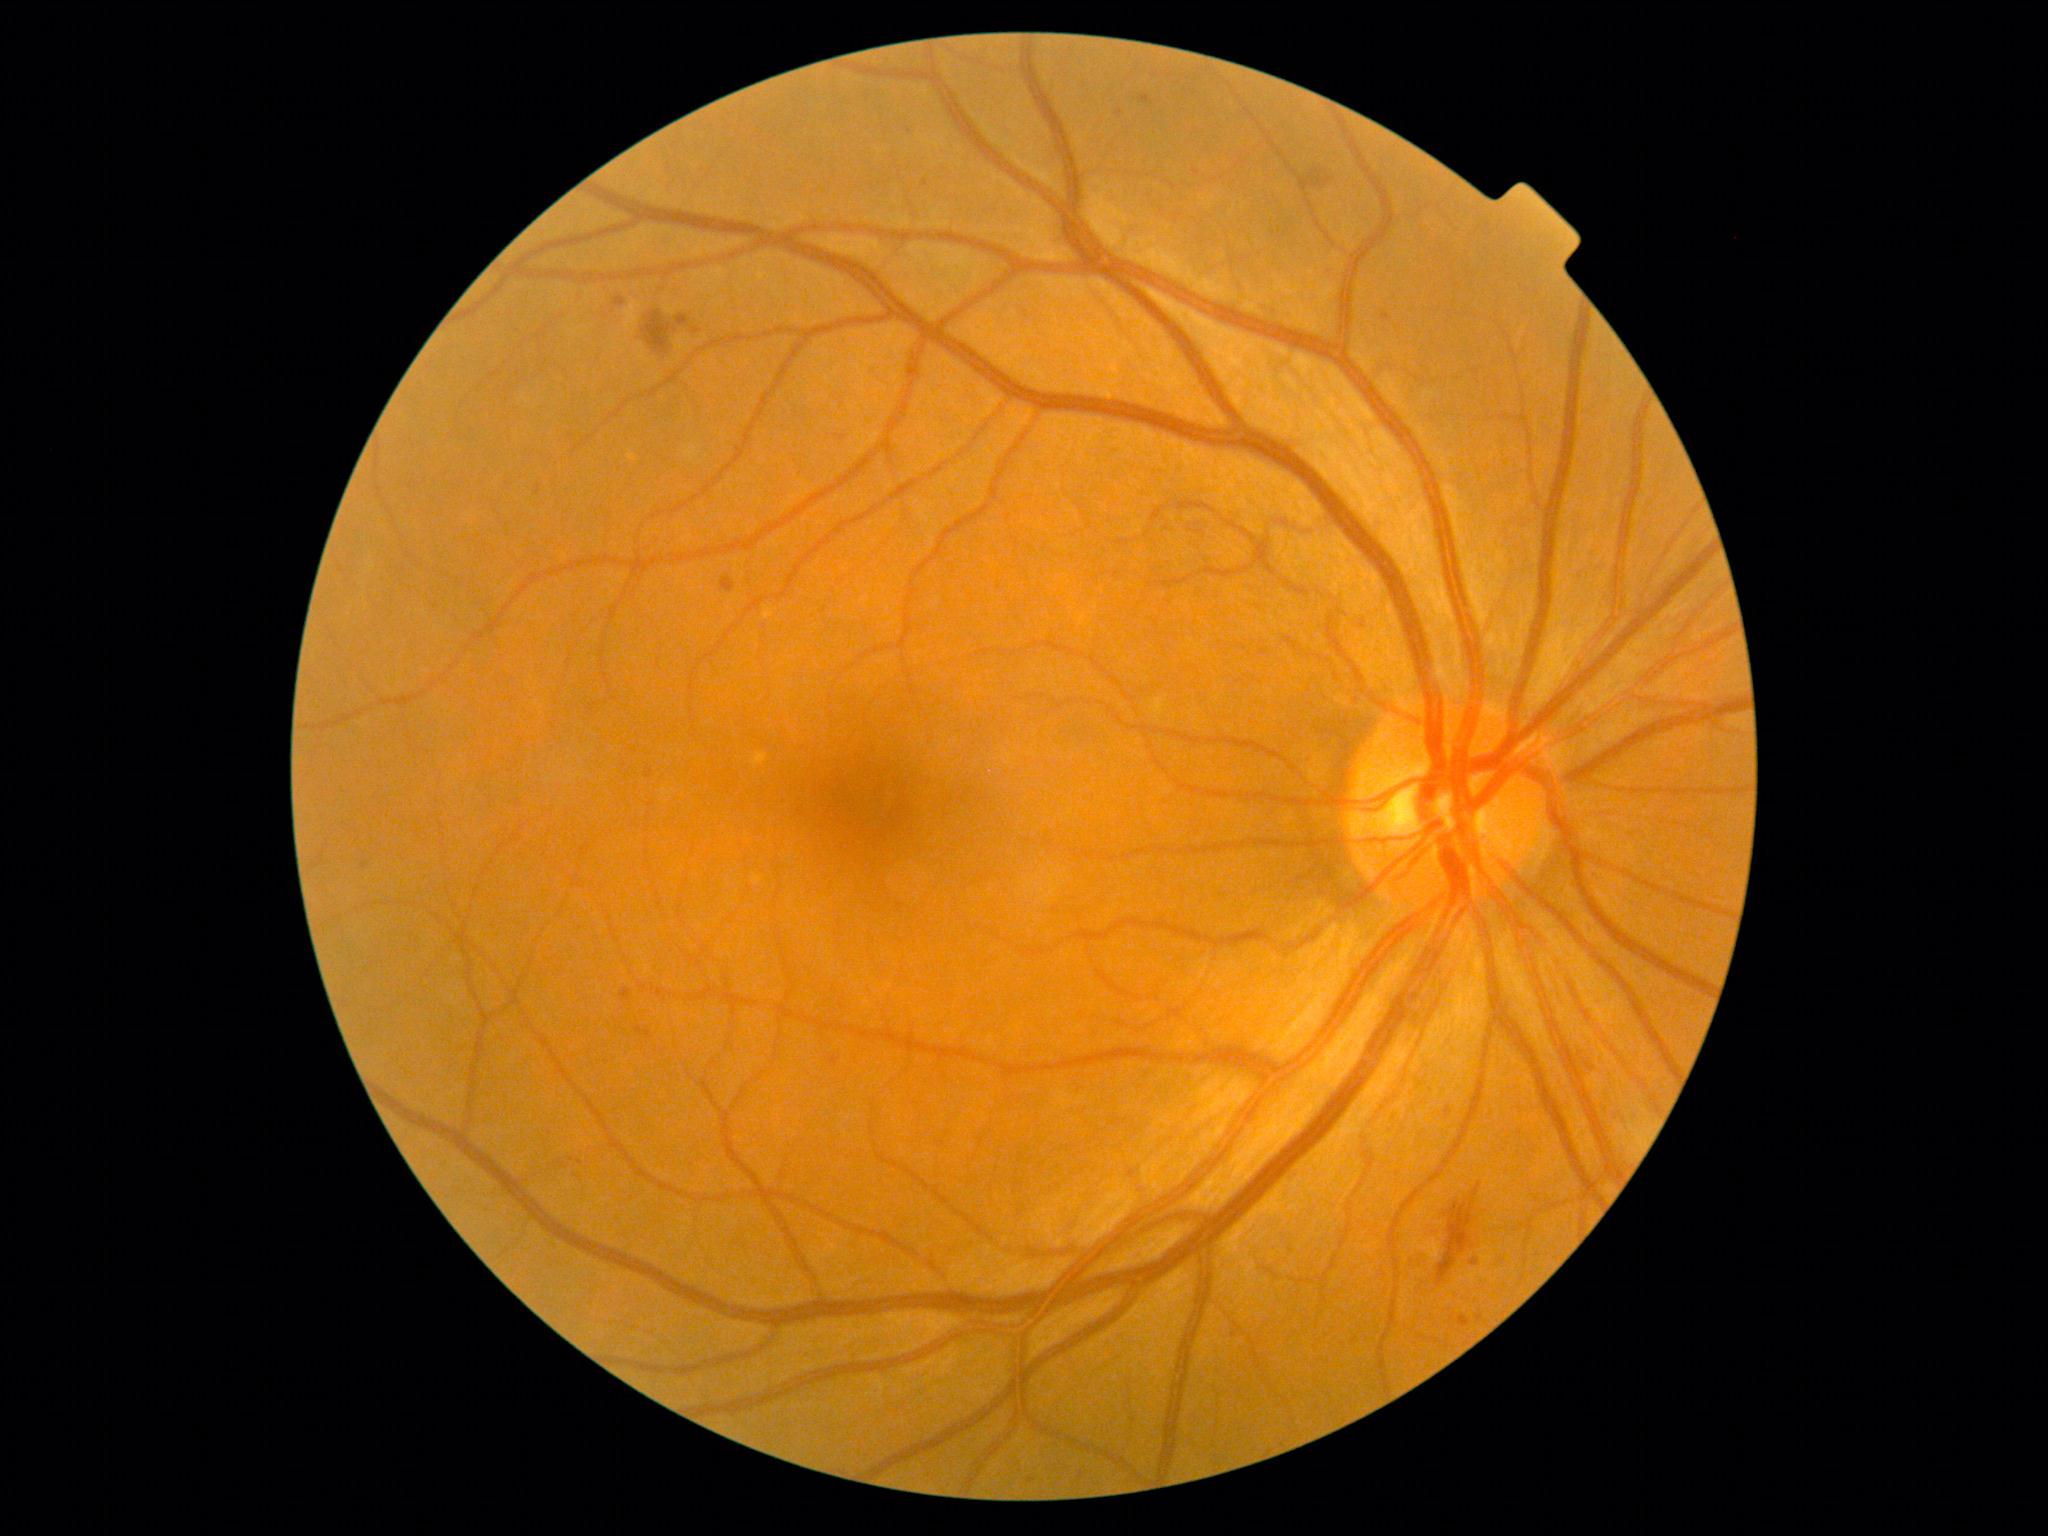
Diabetic retinopathy is moderate NPDR (grade 2).